Modified Davis grading — 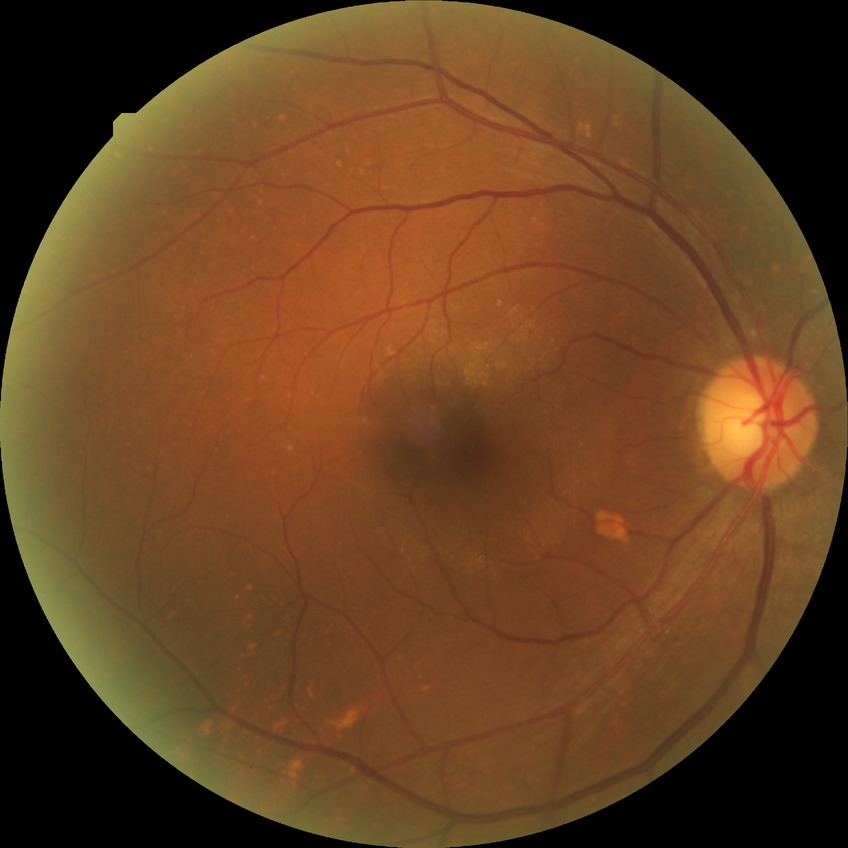
Diabetic retinopathy (DR): no diabetic retinopathy (NDR).